Modified Davis classification · 45° field of view
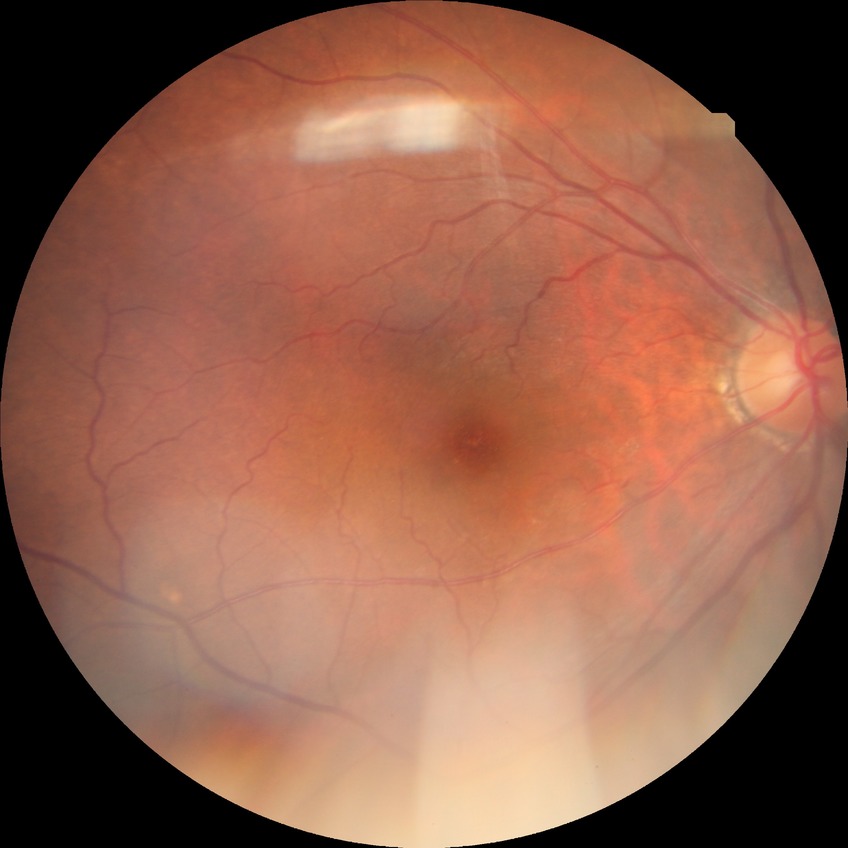

diabetic retinopathy (DR) = NDR (no diabetic retinopathy).